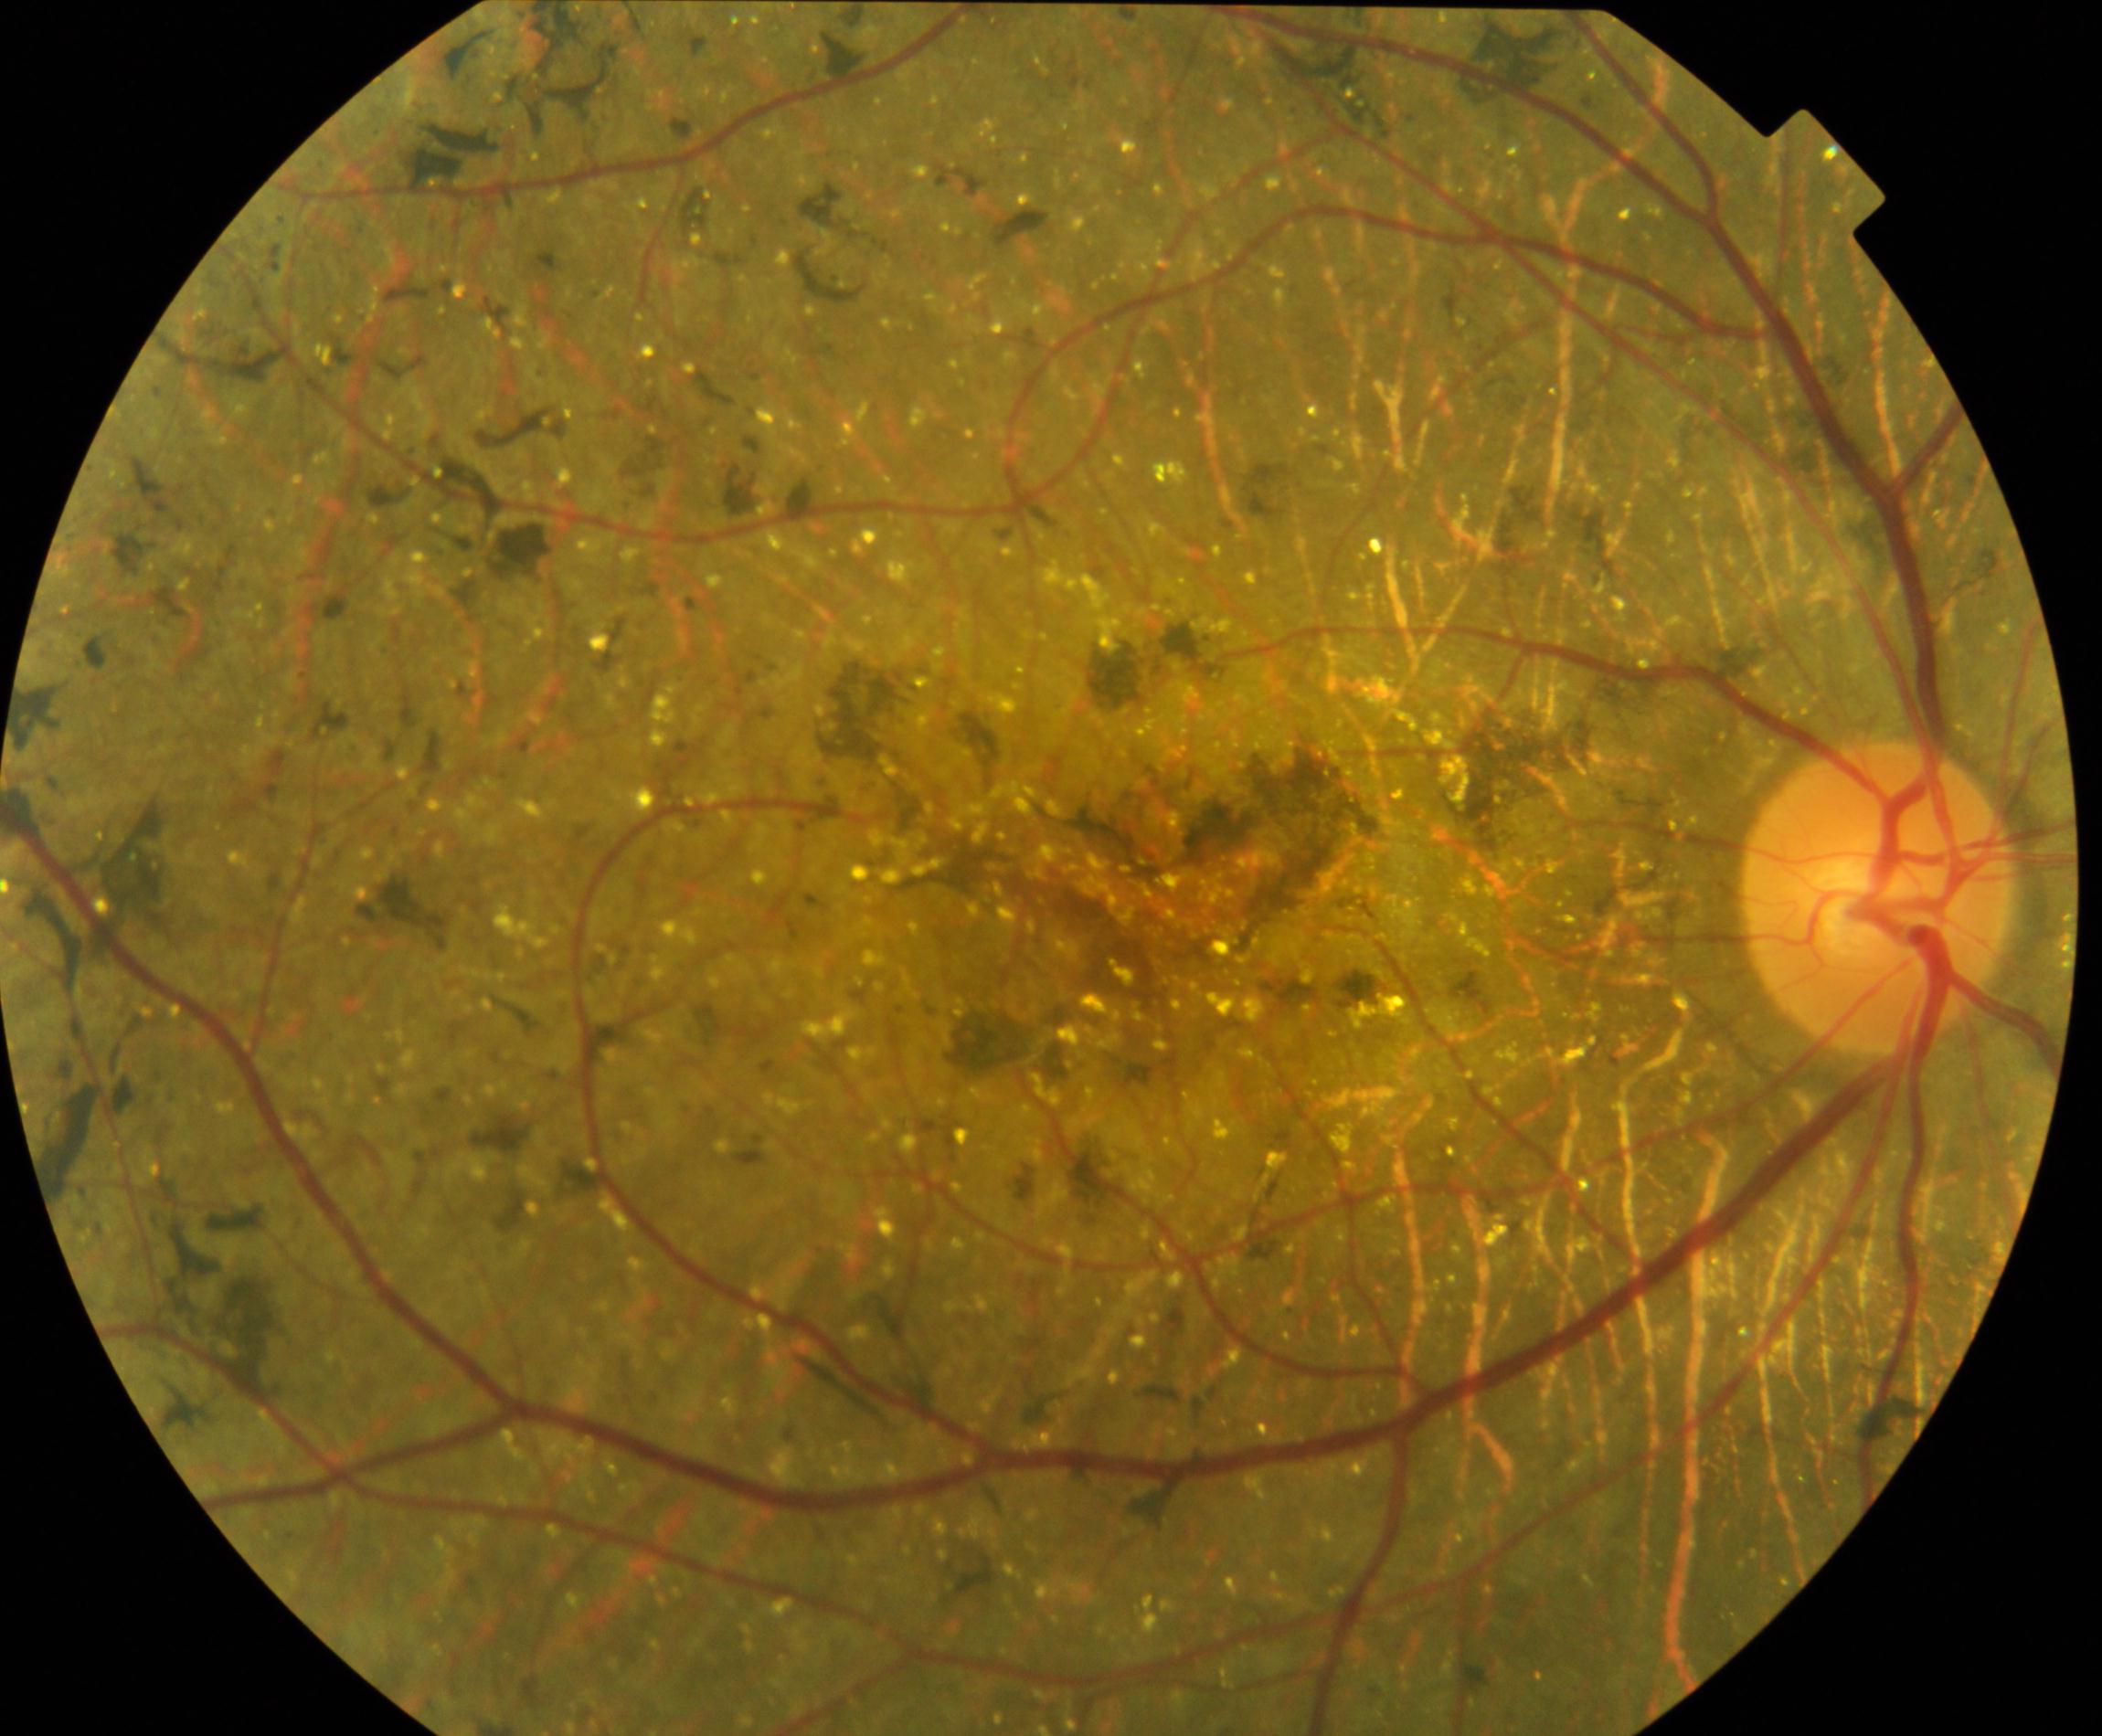 Diagnosis: Bietti crystalline dystrophy.